130° field of view (Clarity RetCam 3); 640x480; wide-field fundus photograph from neonatal ROP screening — 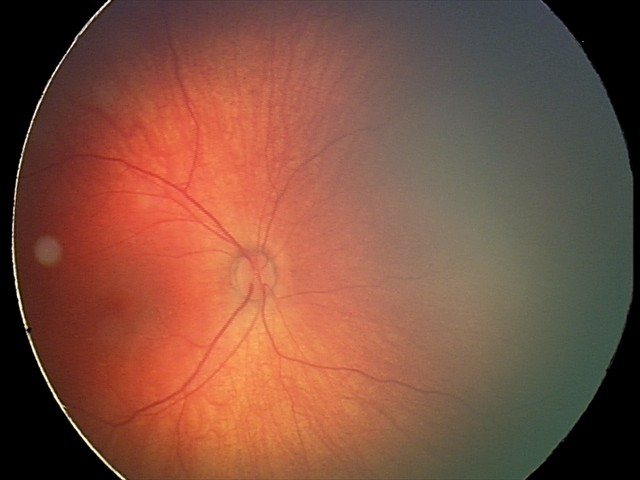
Diagnosis = retinal hemorrhages.